2212 x 1659 pixels:
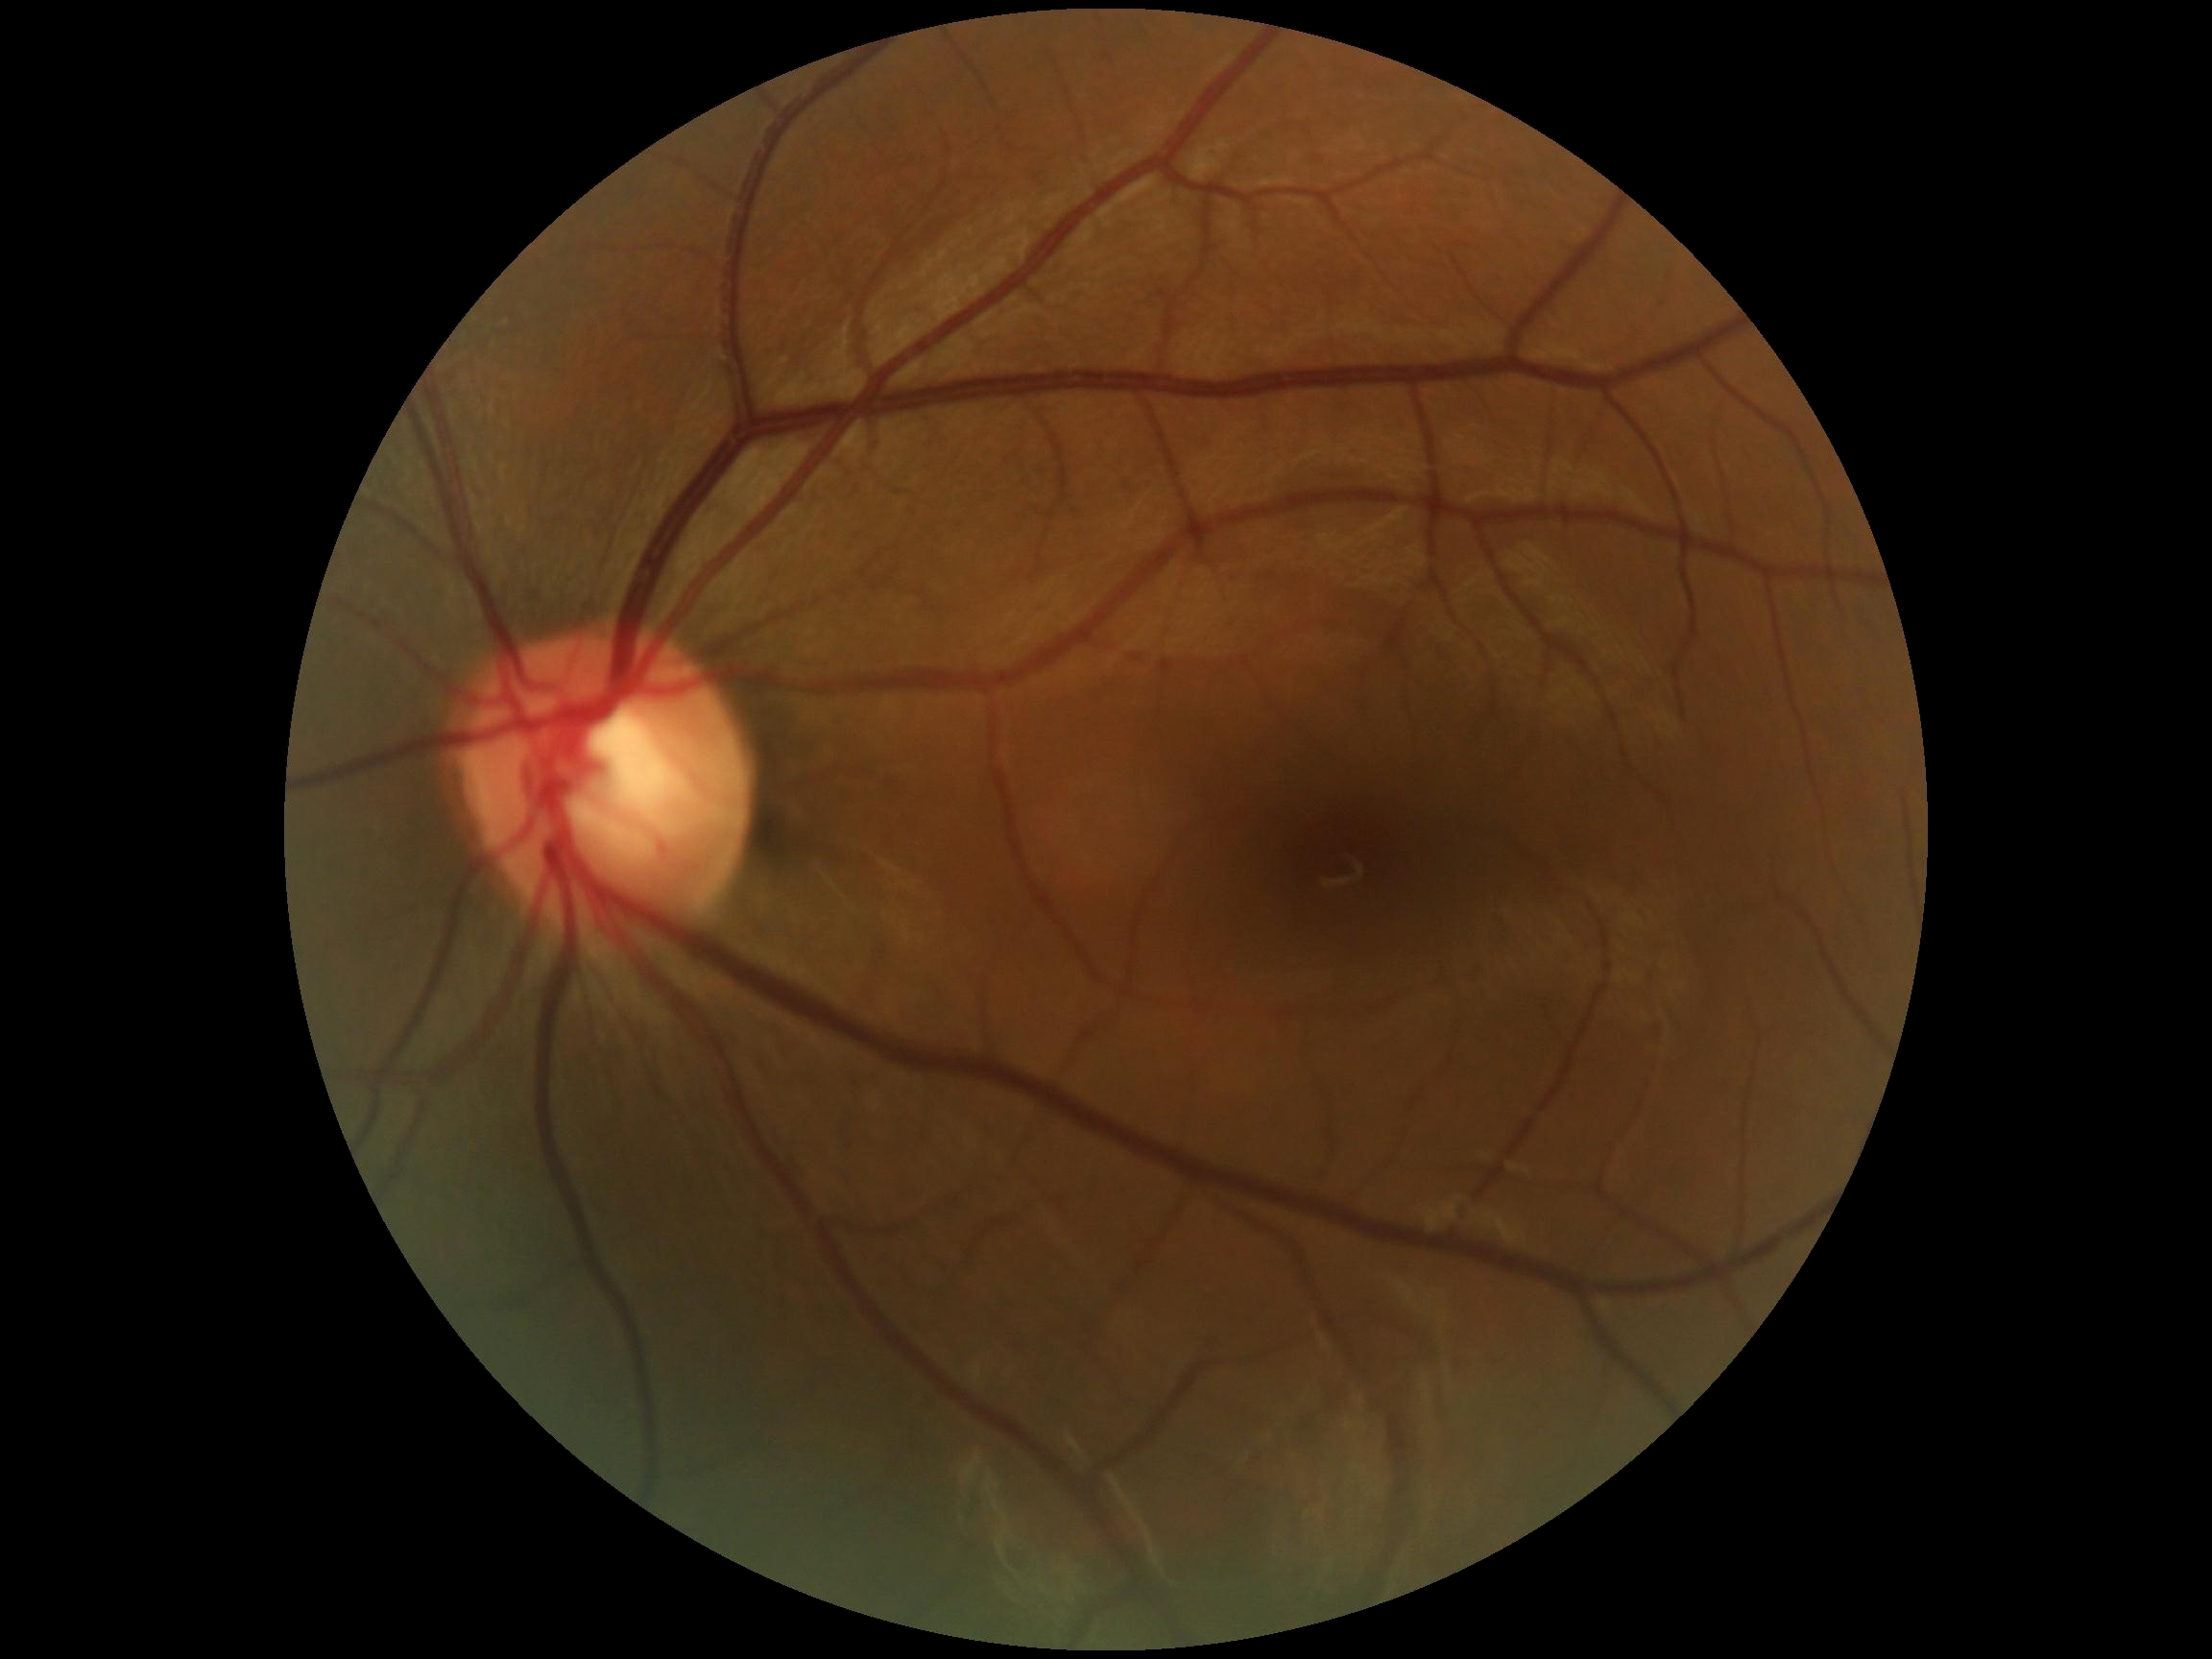

DR grade@0 (no apparent retinopathy), DR impression@no signs of DR.